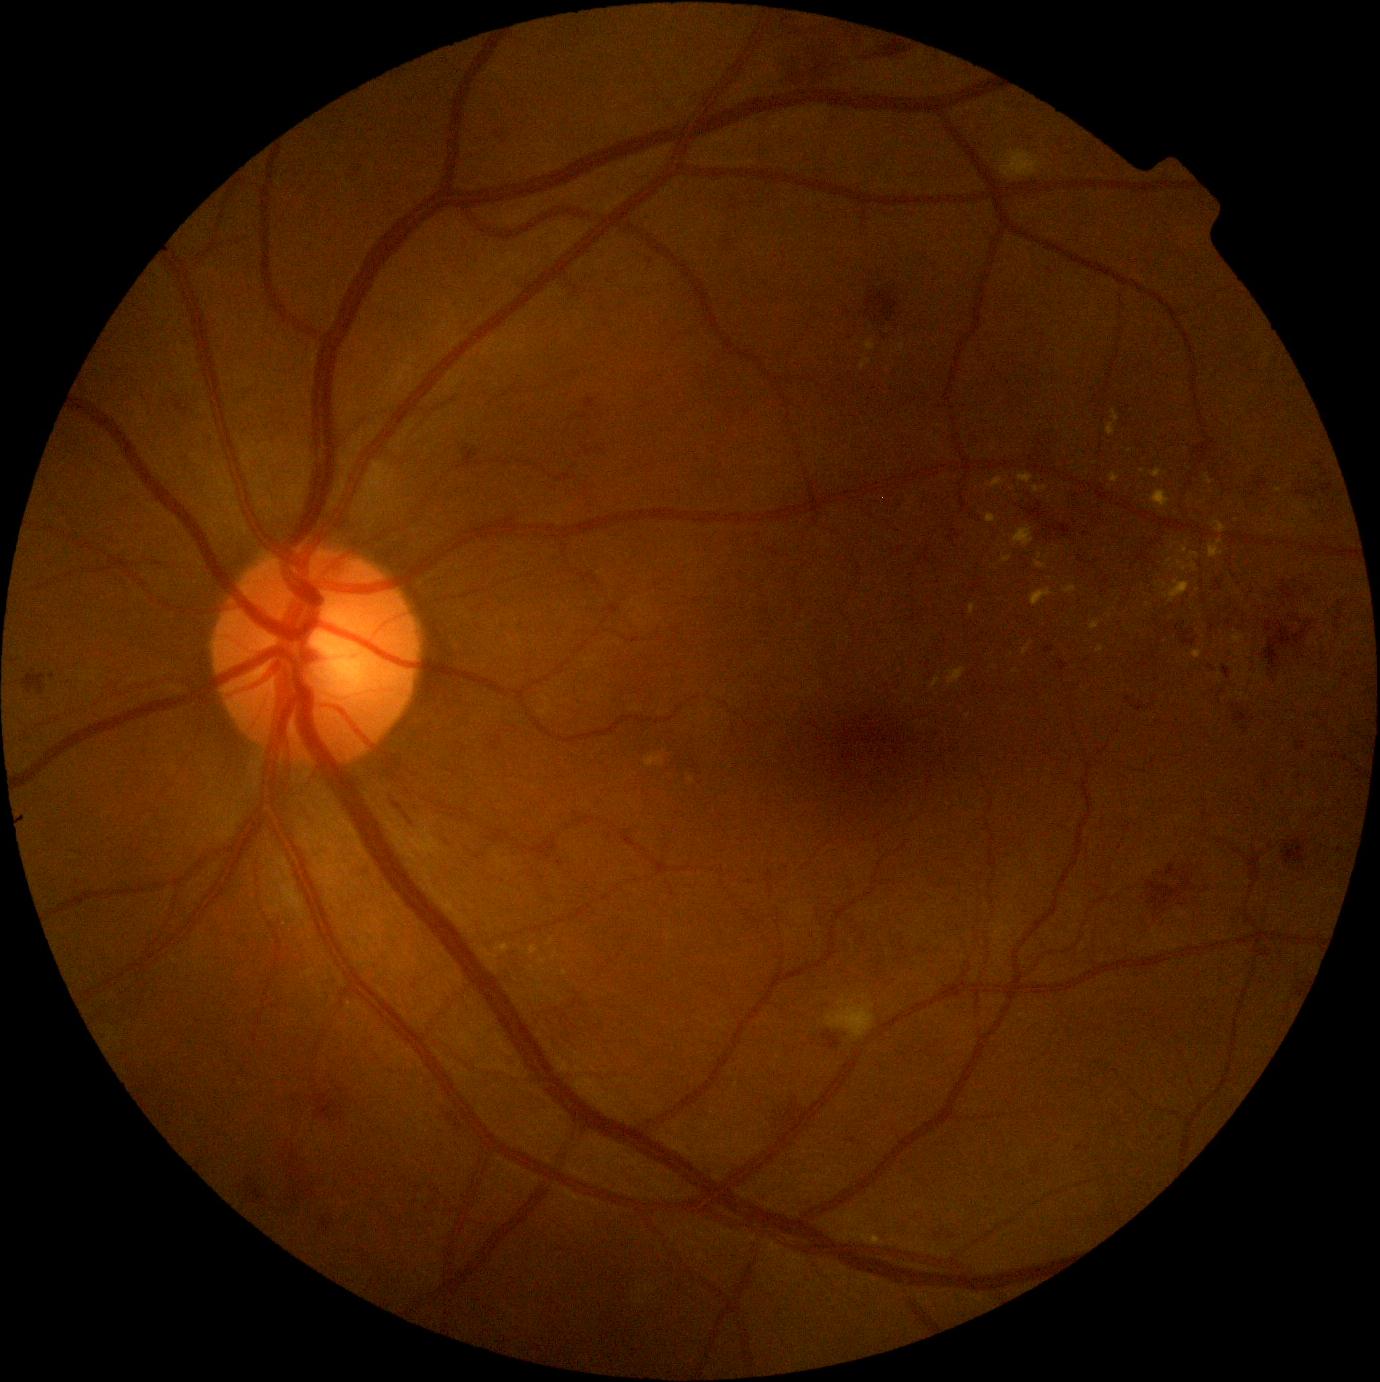 Diabetic retinopathy severity is moderate non-proliferative diabetic retinopathy (grade 2).
The retinopathy is classified as non-proliferative diabetic retinopathy.